Wide-field contact fundus photograph of an infant; captured with the Phoenix ICON (100° field of view); 1240 x 1240 pixels.
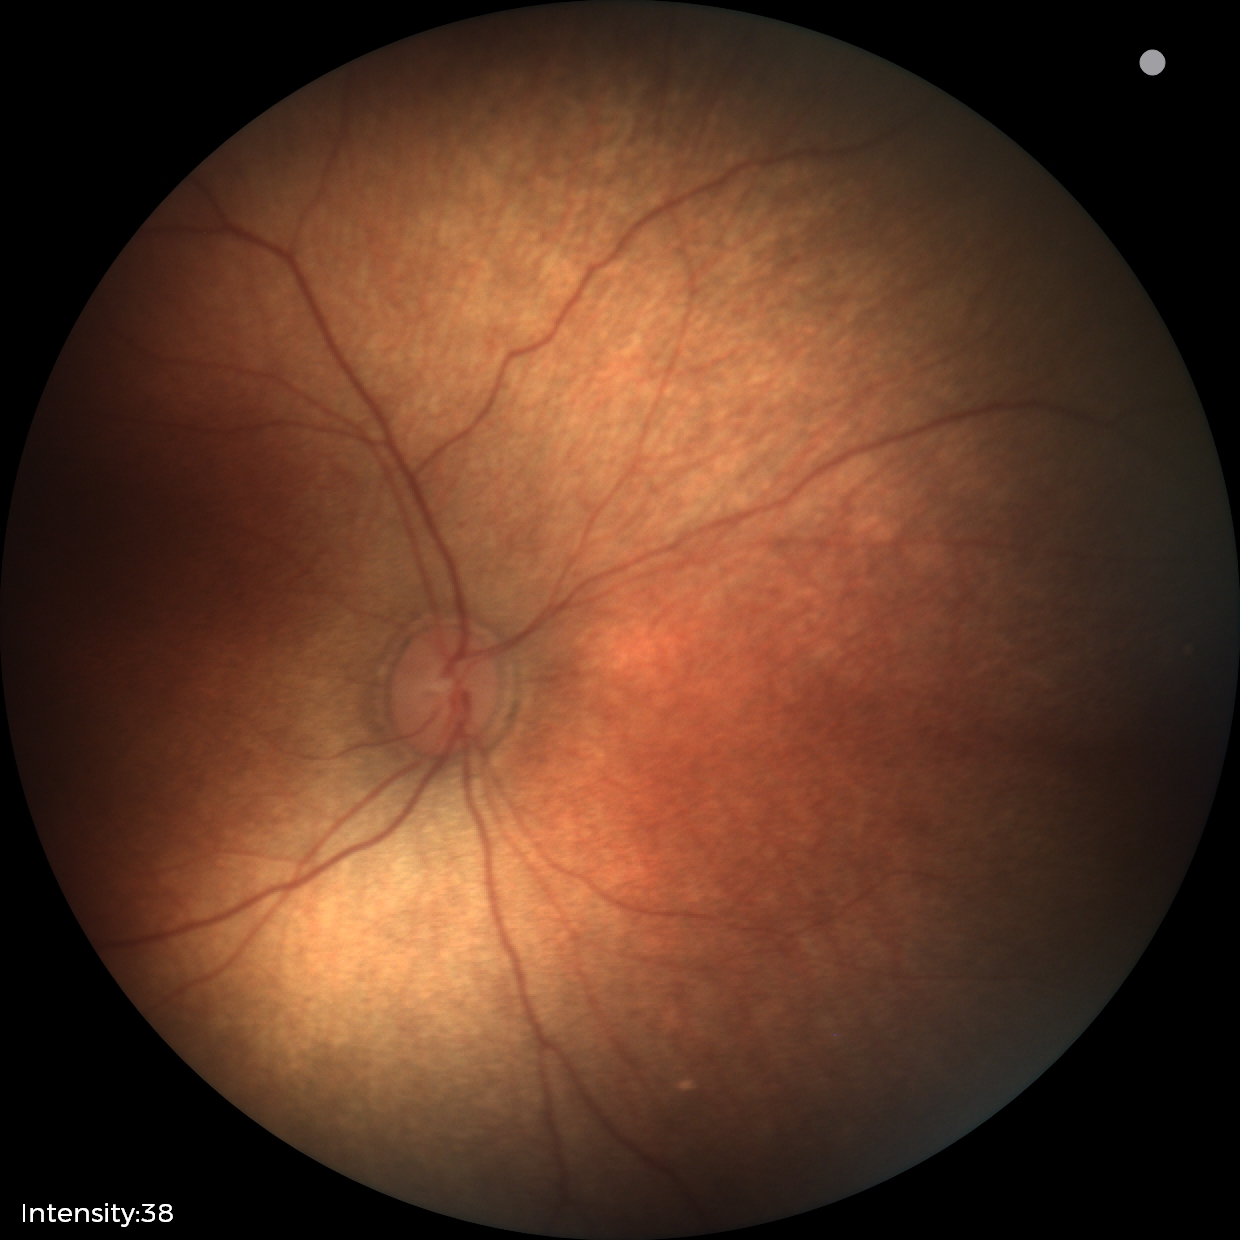 Normal screening examination.